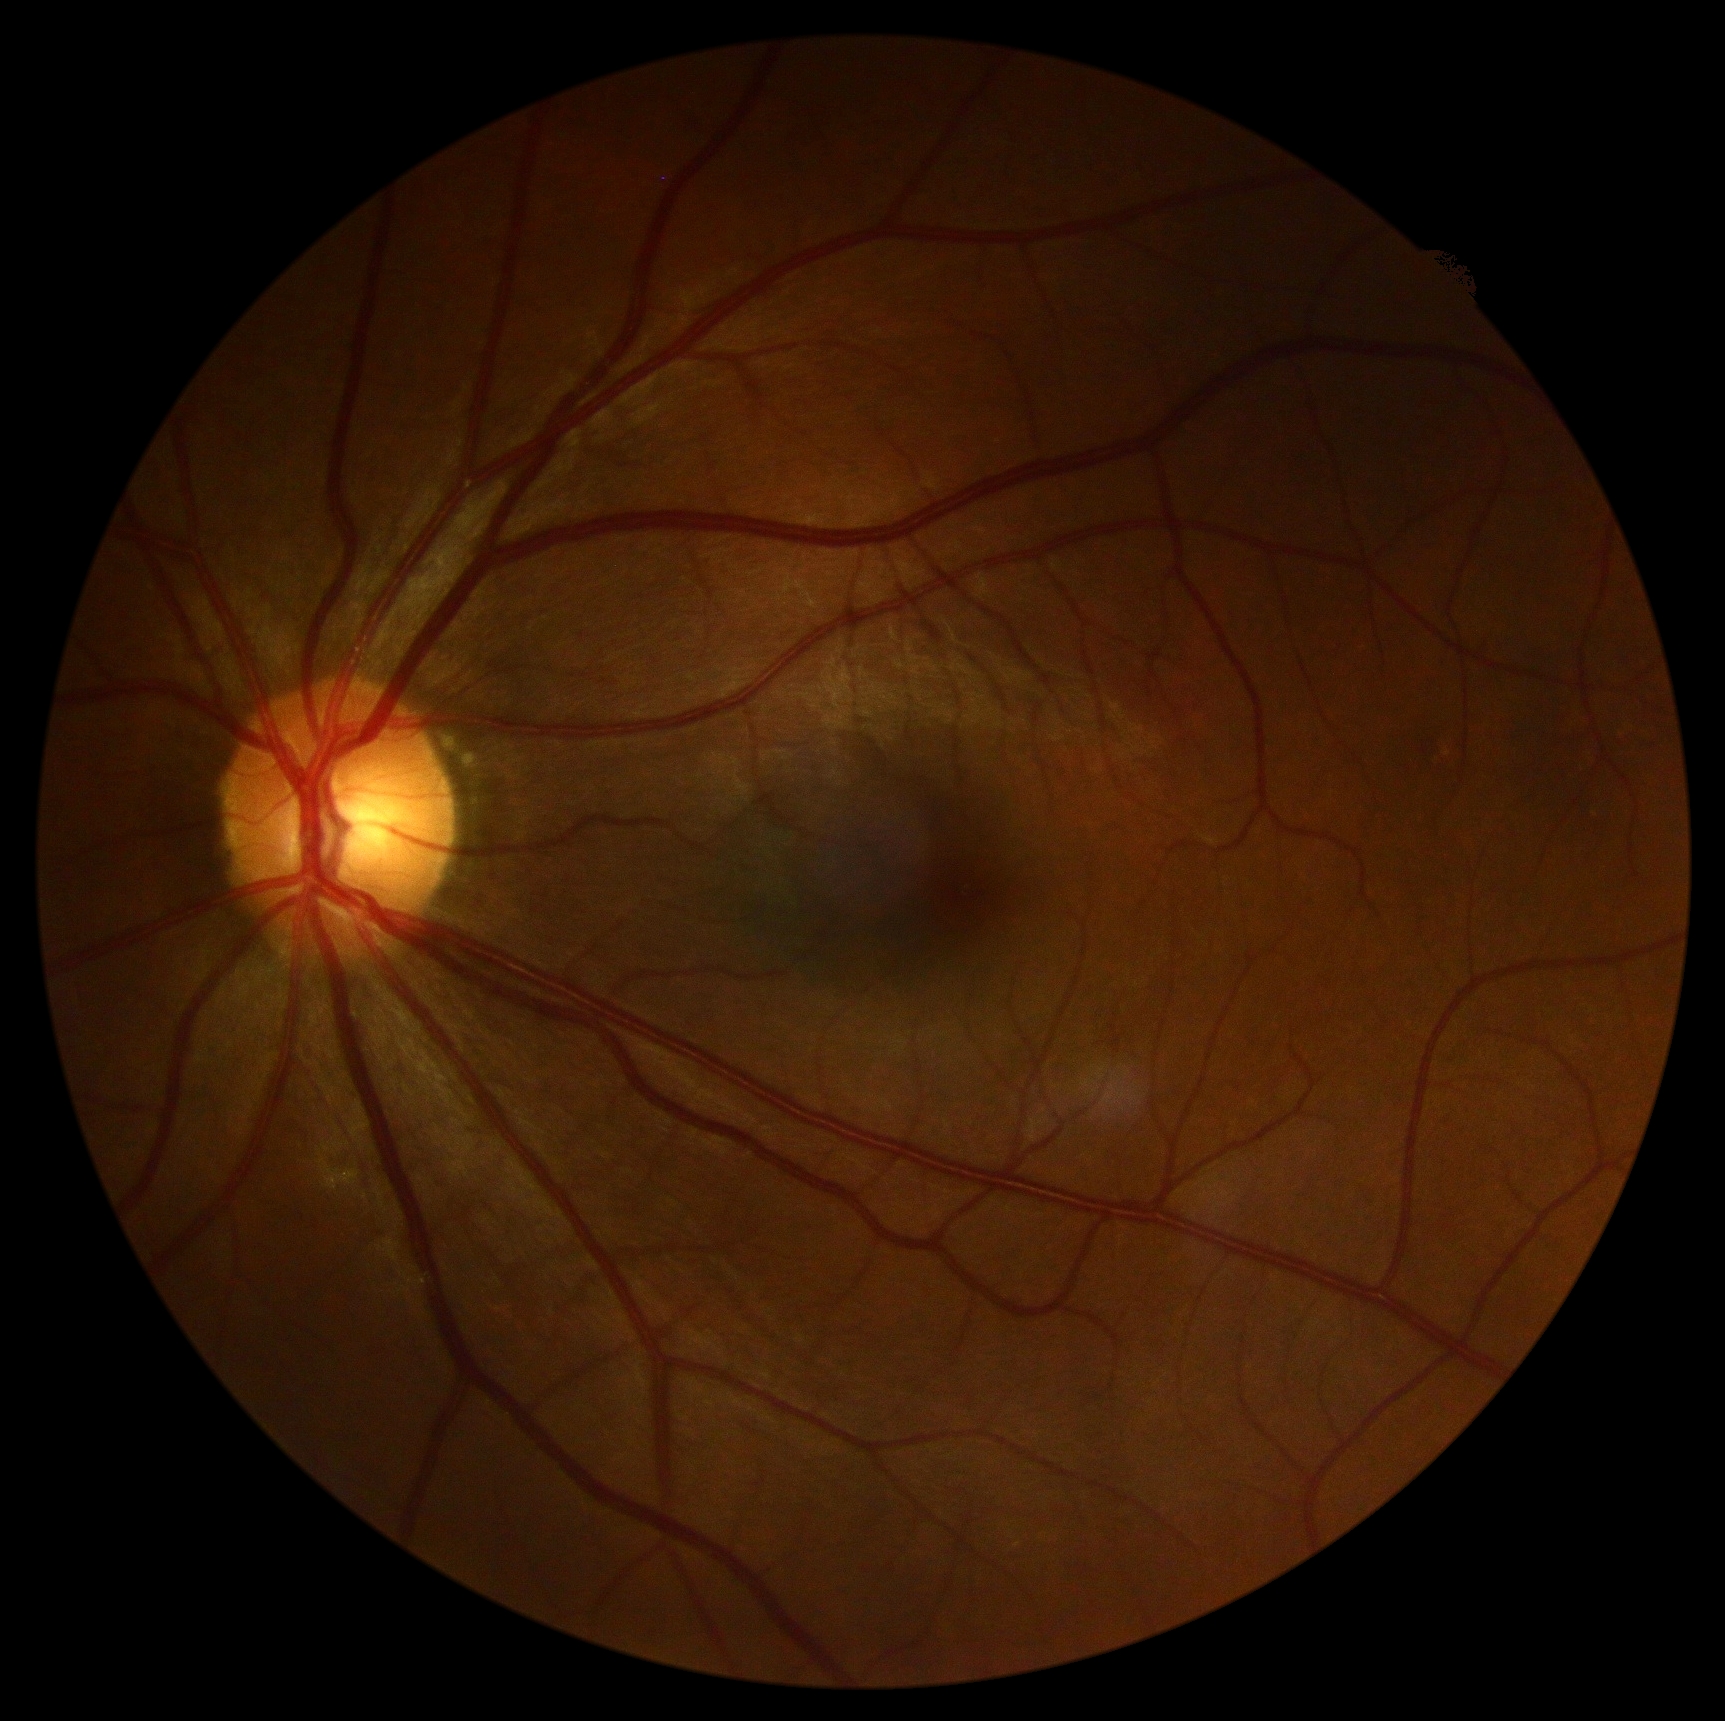

DR stage: 0 — no visible signs of diabetic retinopathy. No diabetic retinal disease findings.